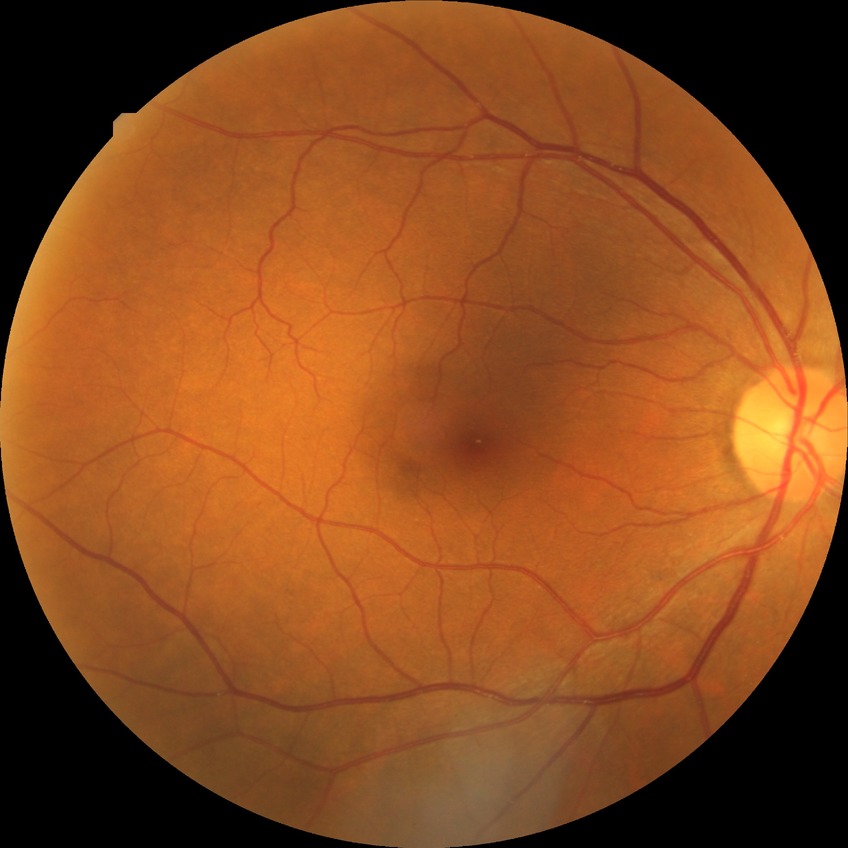 Modified Davis classification: no diabetic retinopathy.